NIDEK AFC-230.
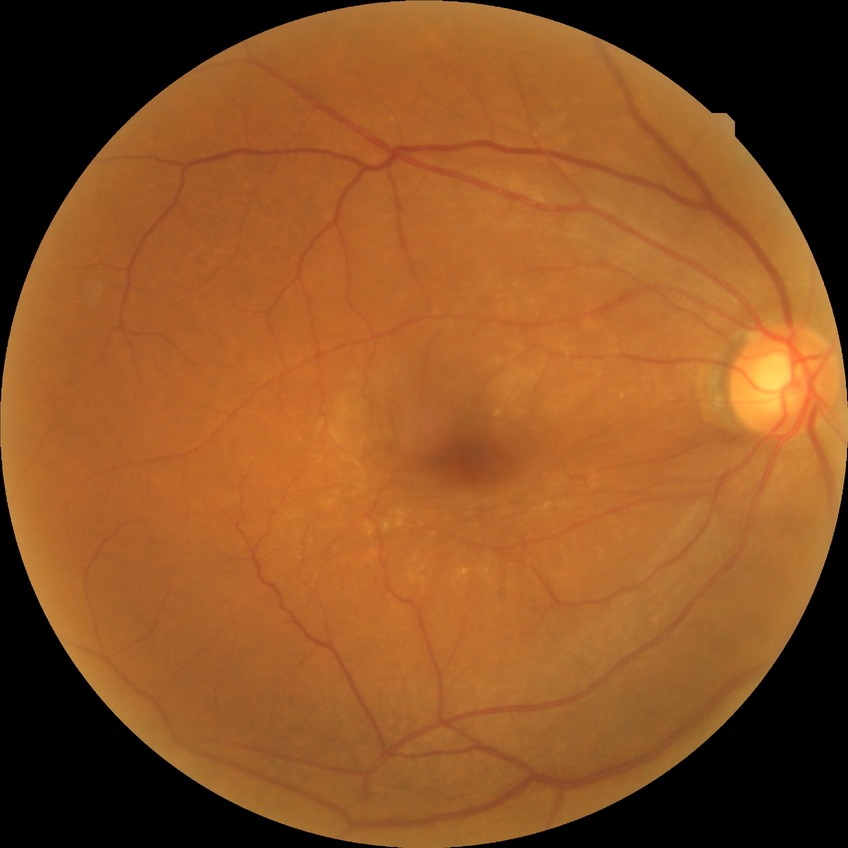
Modified Davis grade is NDR.